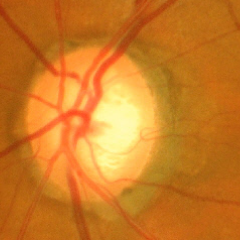
Optic disc appearance consistent with early glaucoma. Diagnostic criteria: glaucomatous retinal nerve fiber layer defects on red-free fundus photography without visual field defects.